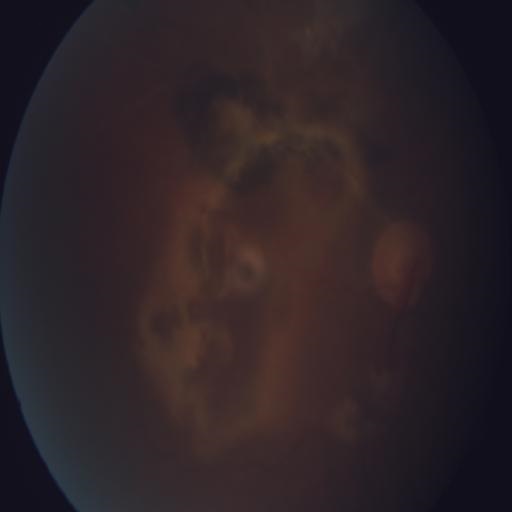

Findings (2): macular scar (MS), chorioretinitis (CRS).